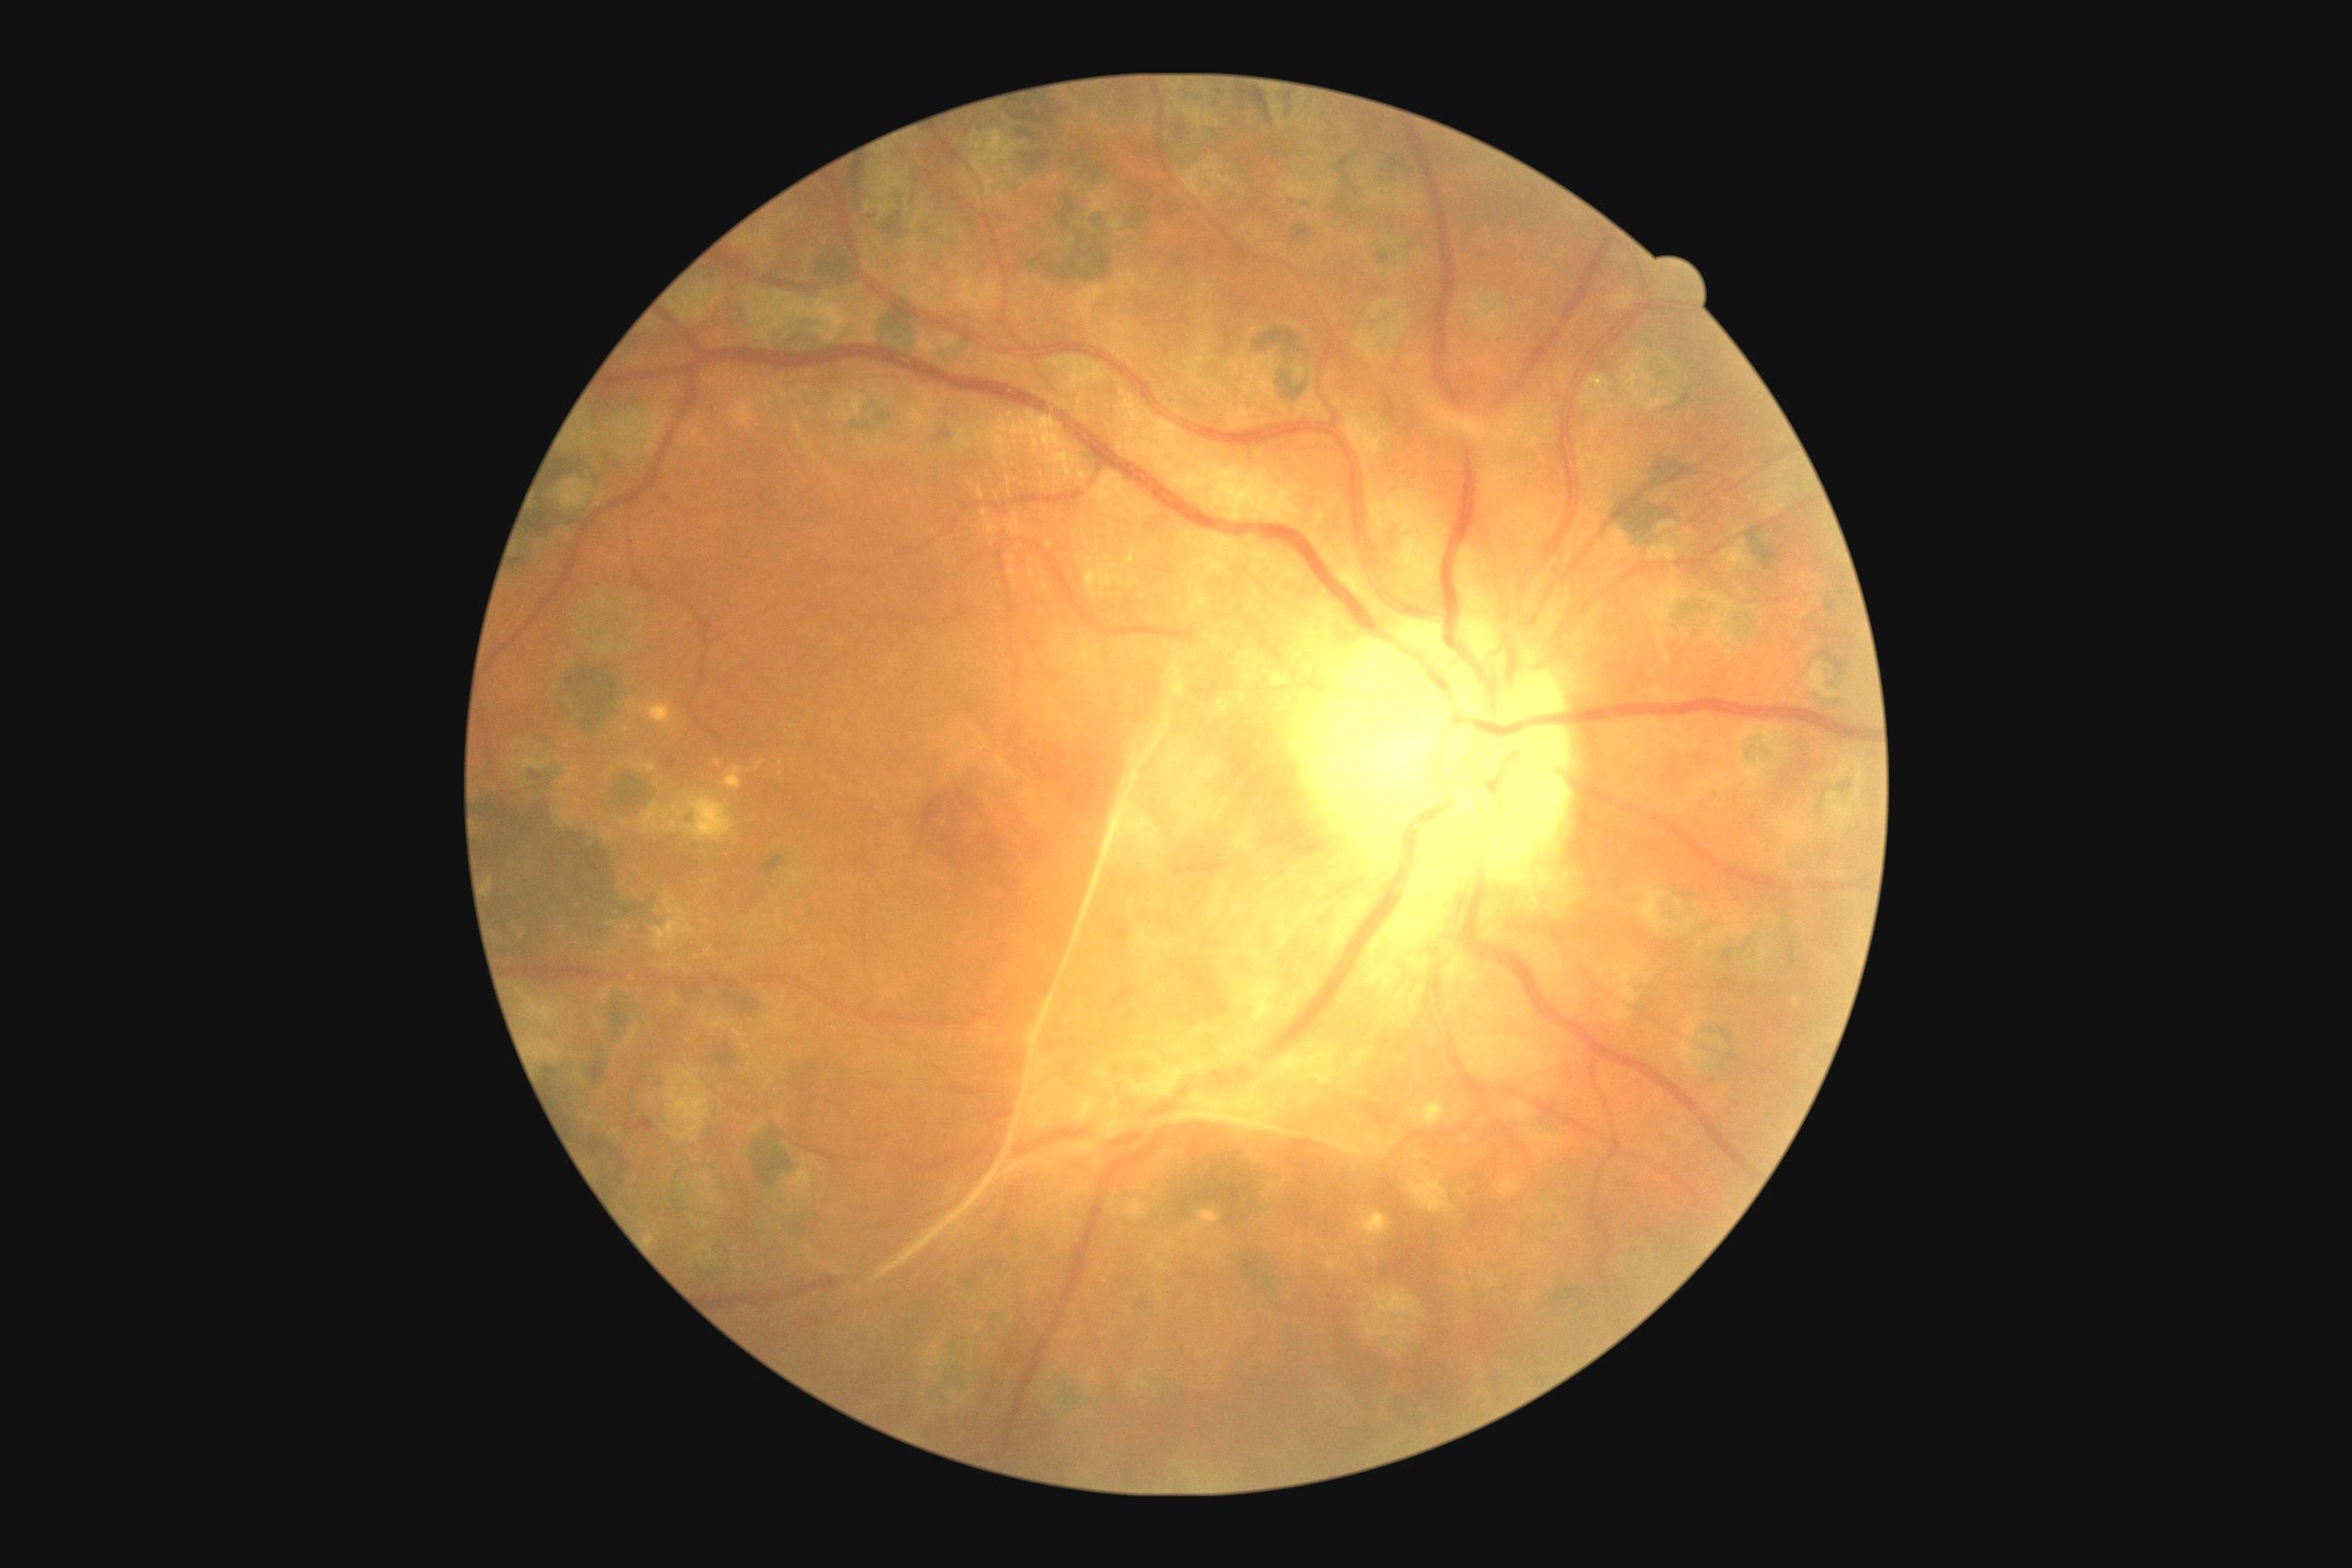
DR stage: 4.